2212x1659px · 45° field of view · color fundus image — 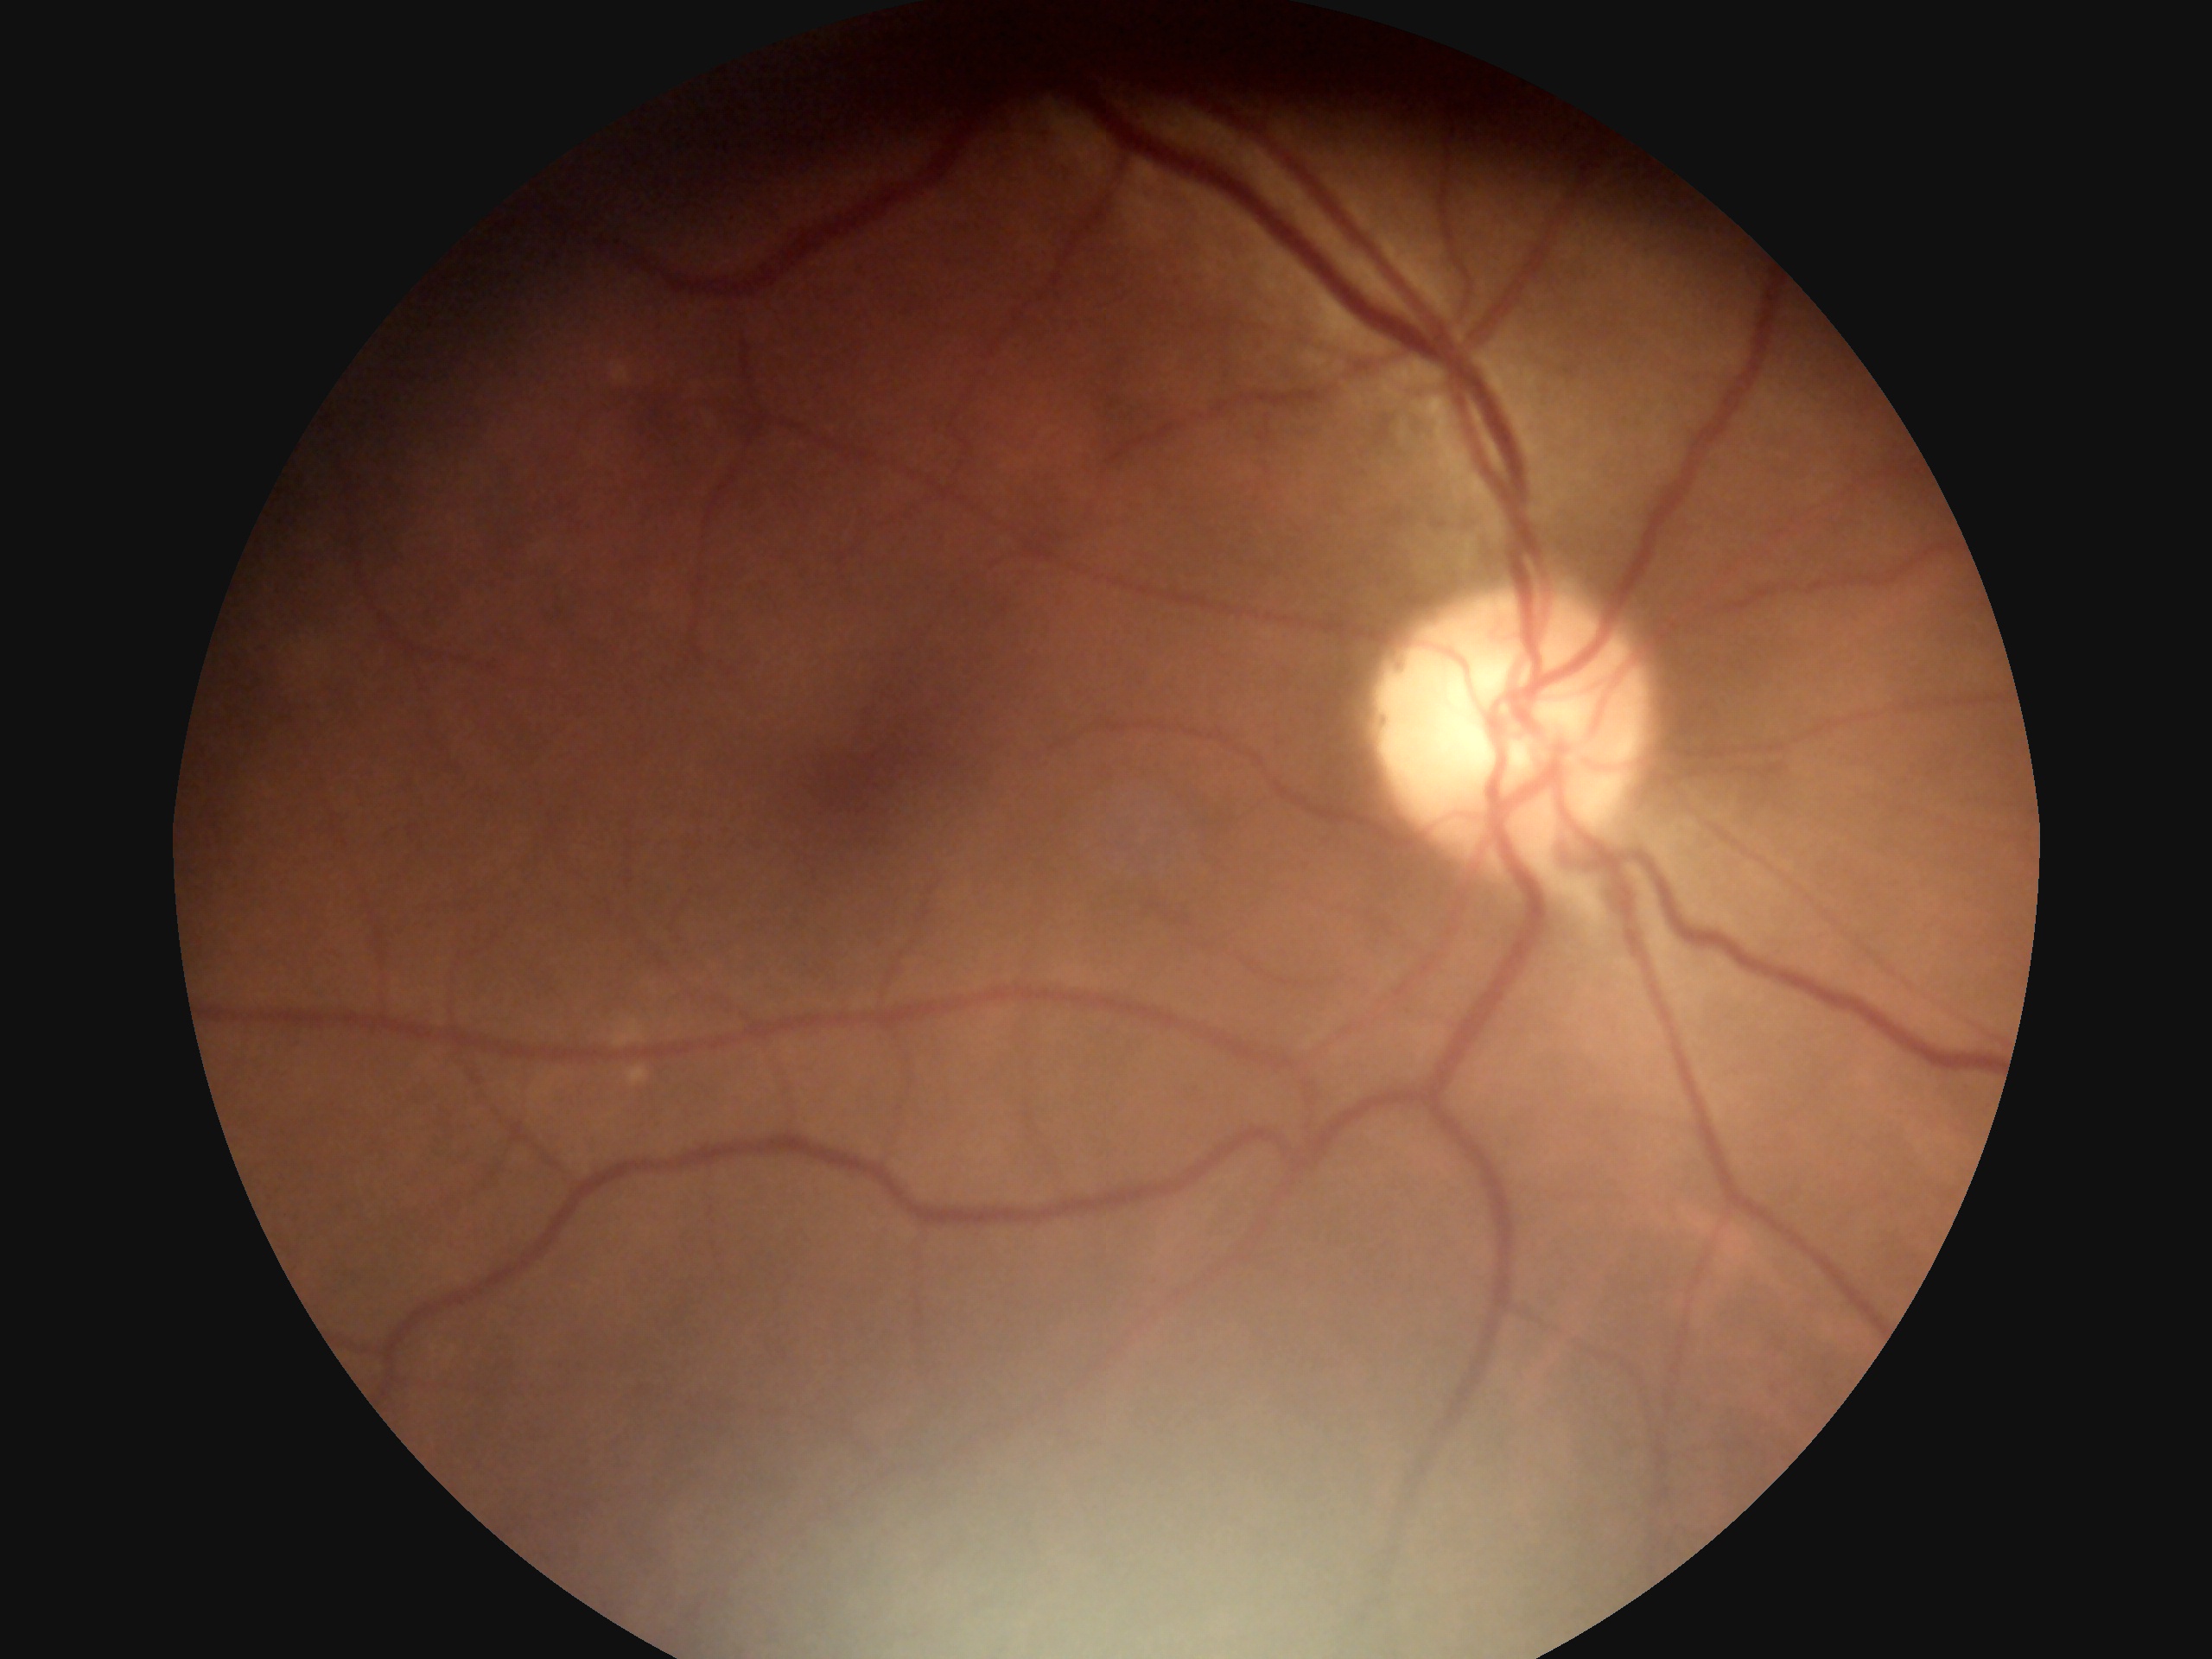
Diabetic retinopathy grade is 0 (no apparent retinopathy).